Davis DR grading; NIDEK AFC-230.
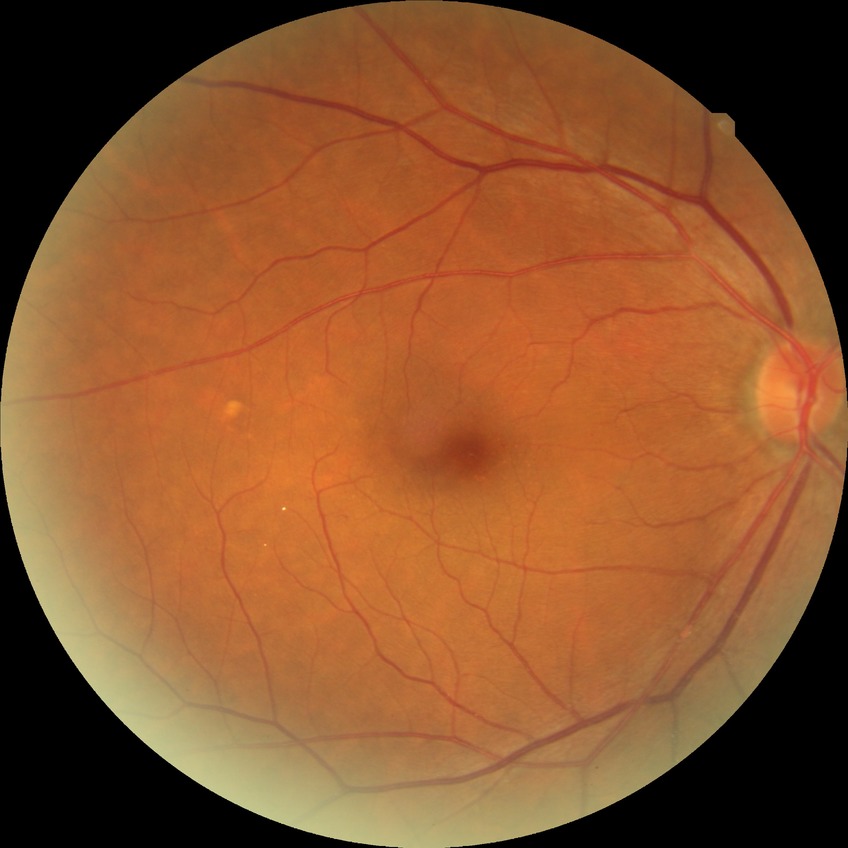
Retinopathy grade: no diabetic retinopathy.